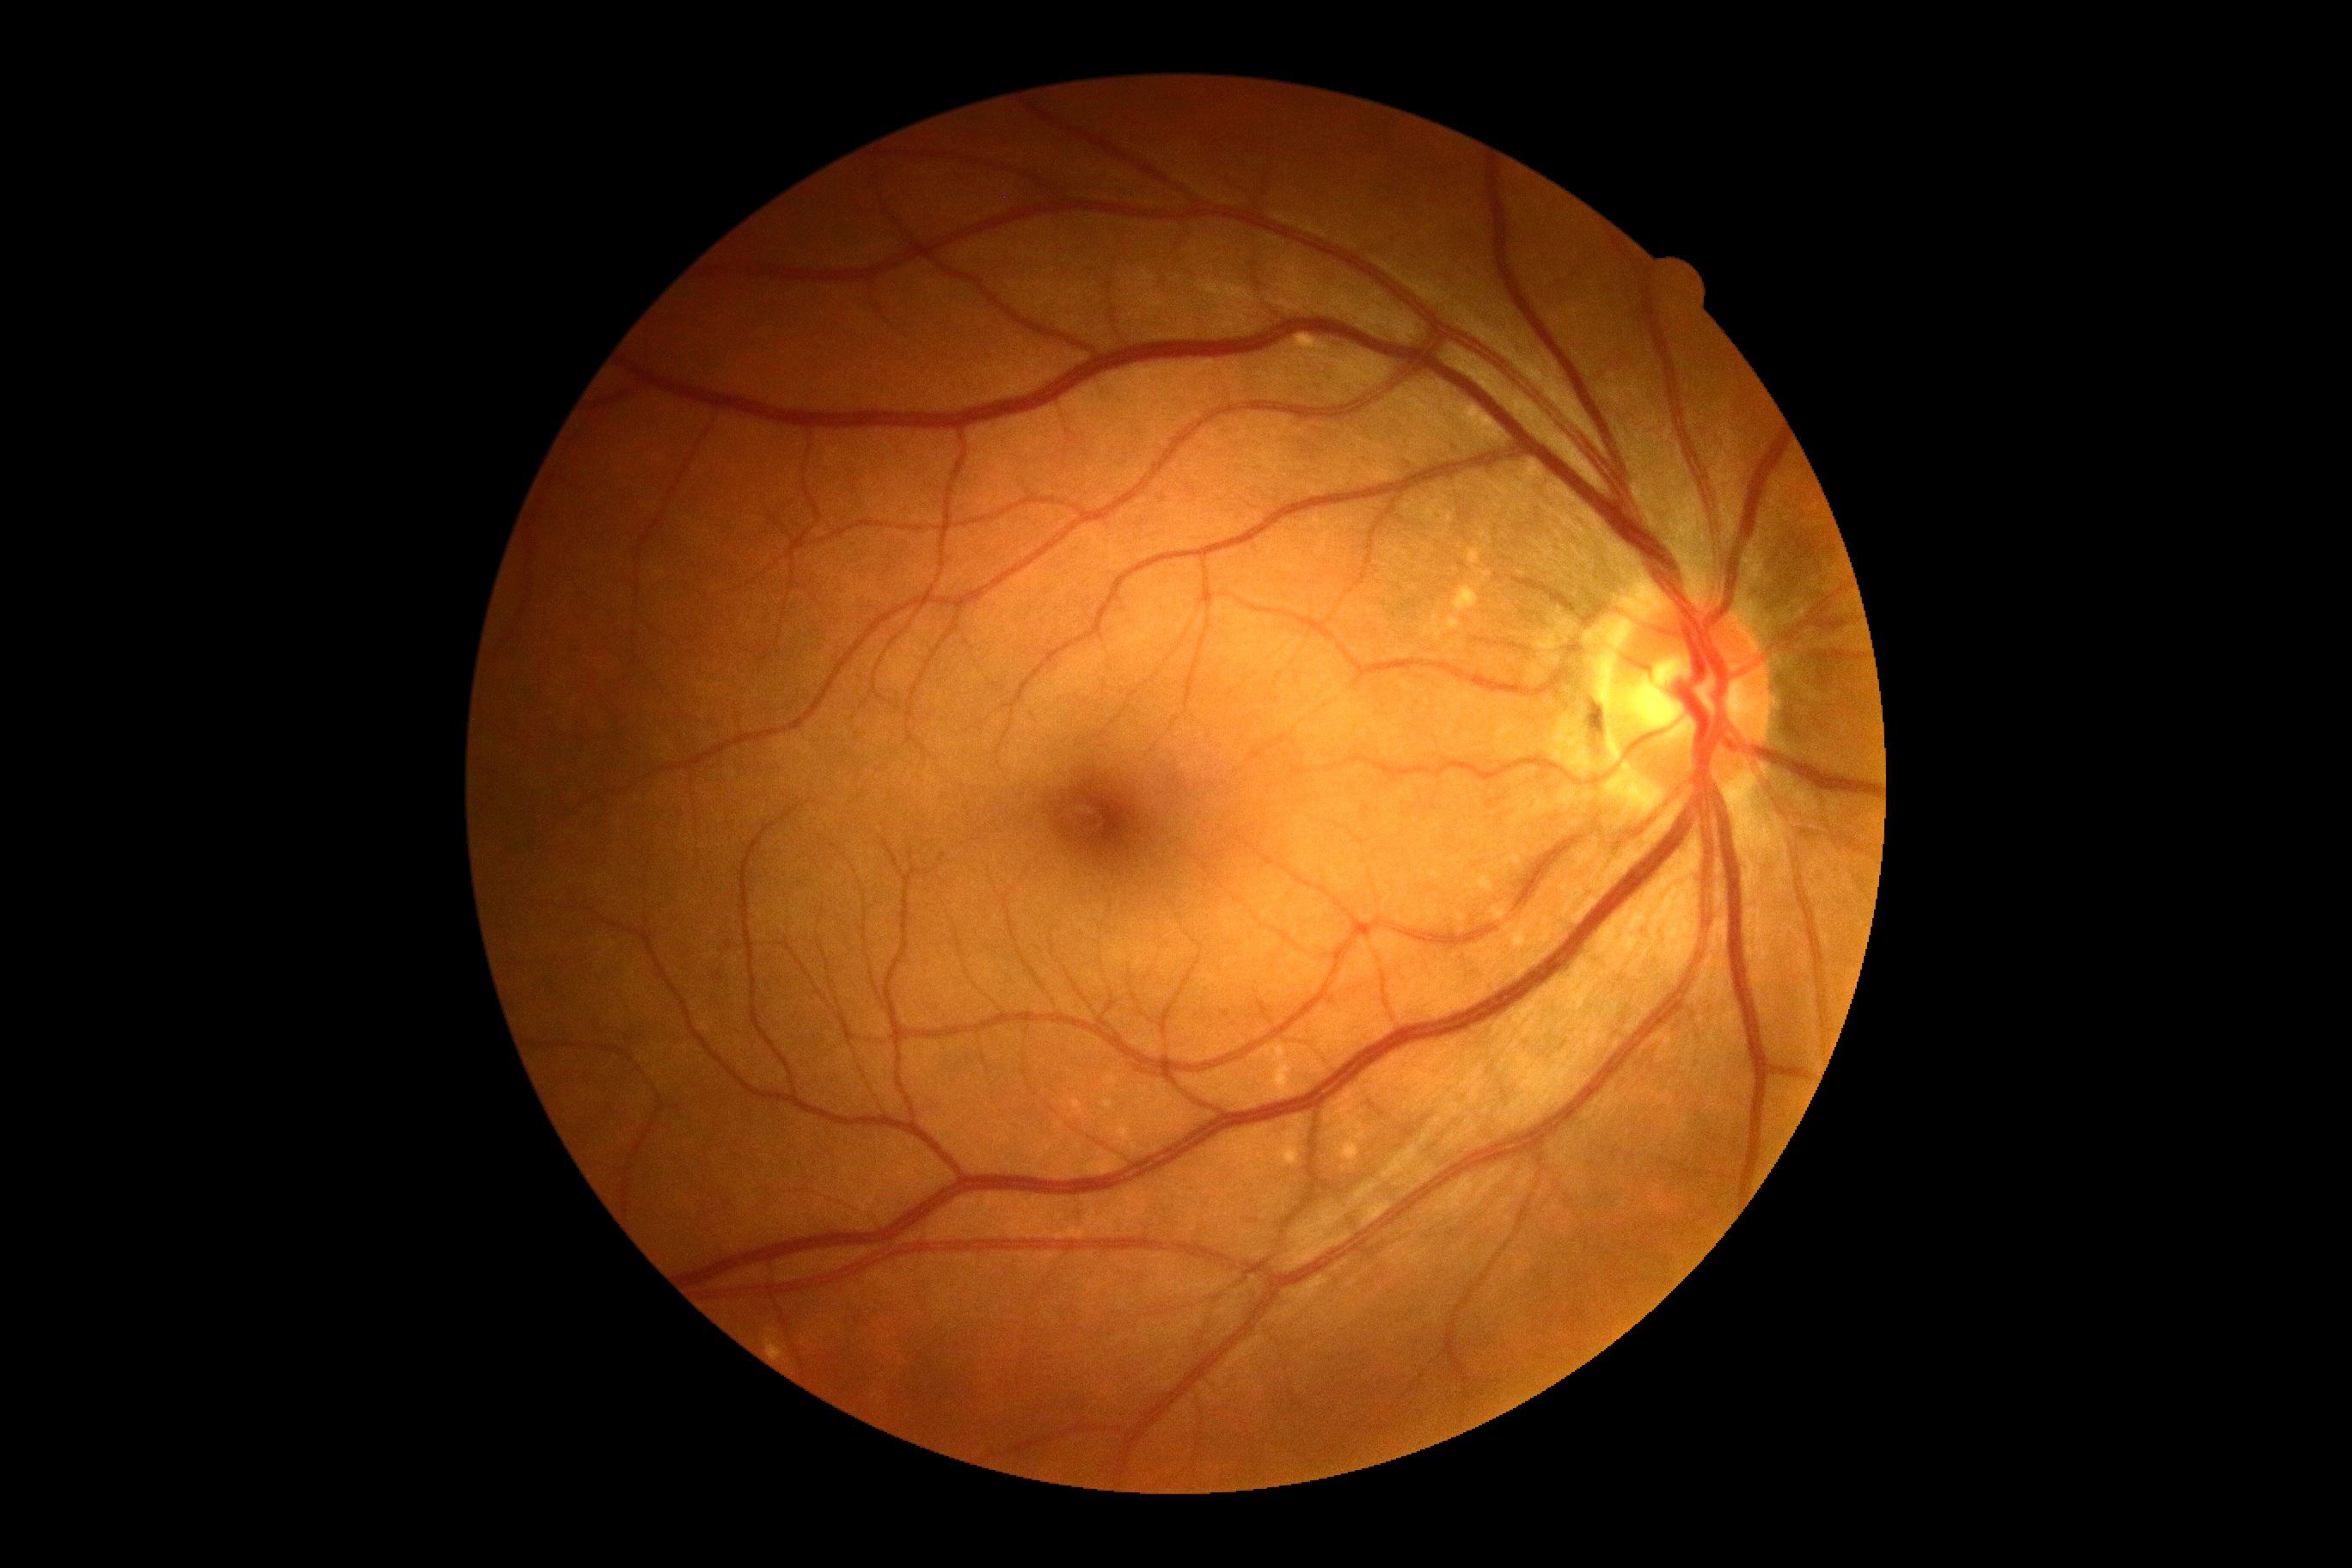

Diabetic retinopathy (DR): 0/4.